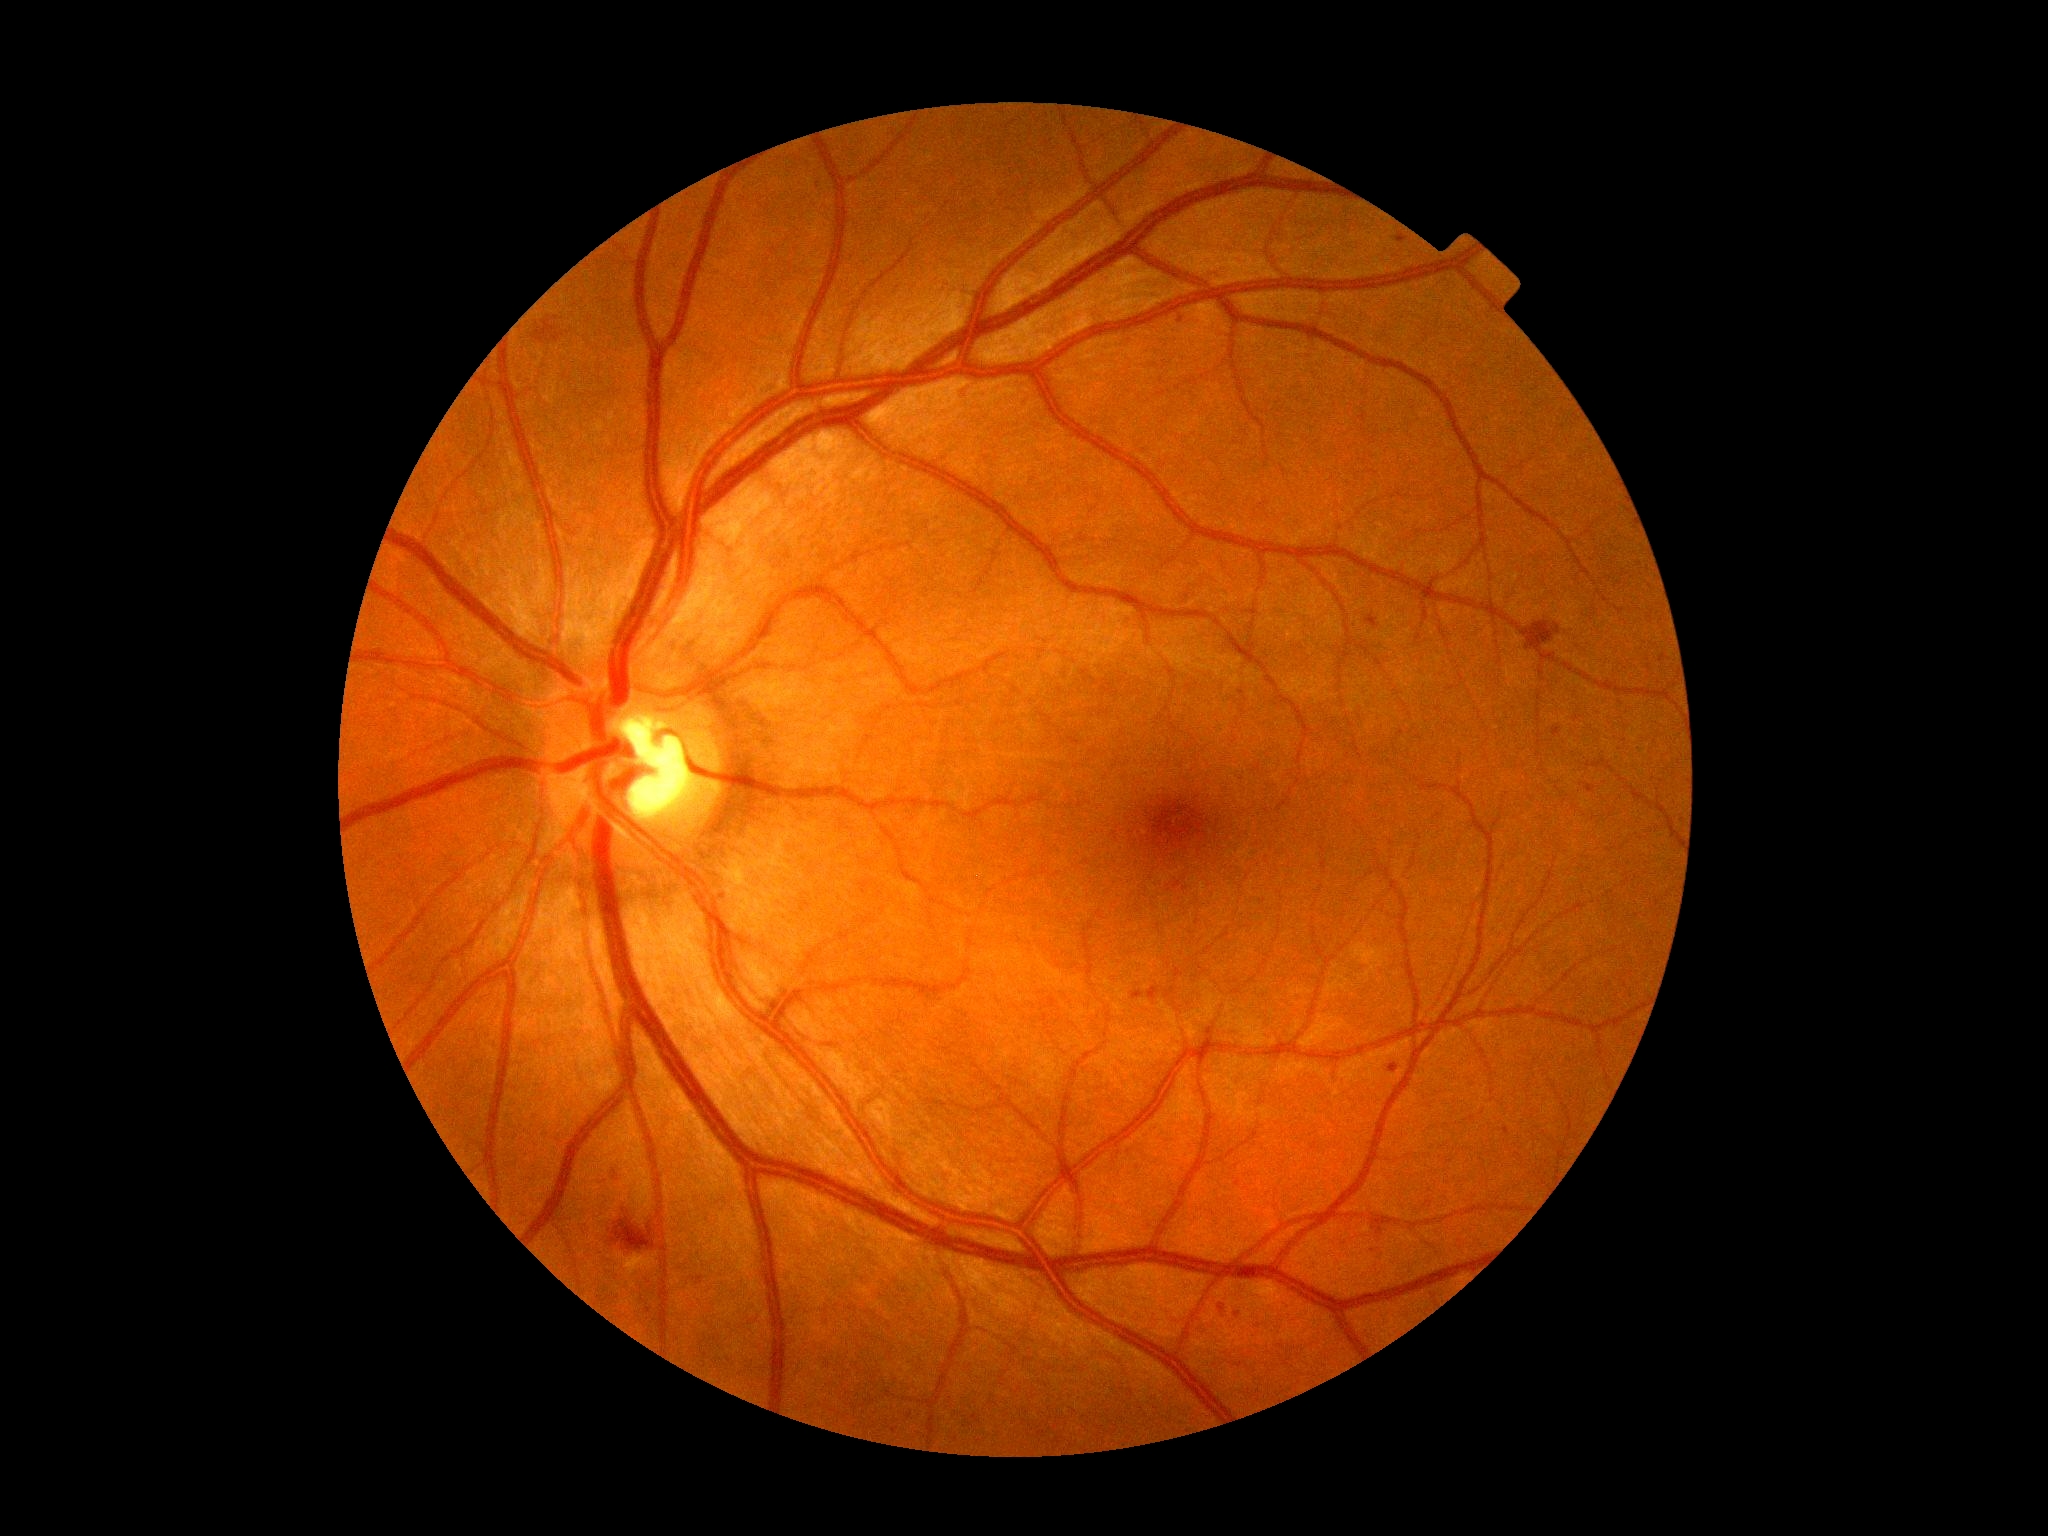

DR stage is 2/4.